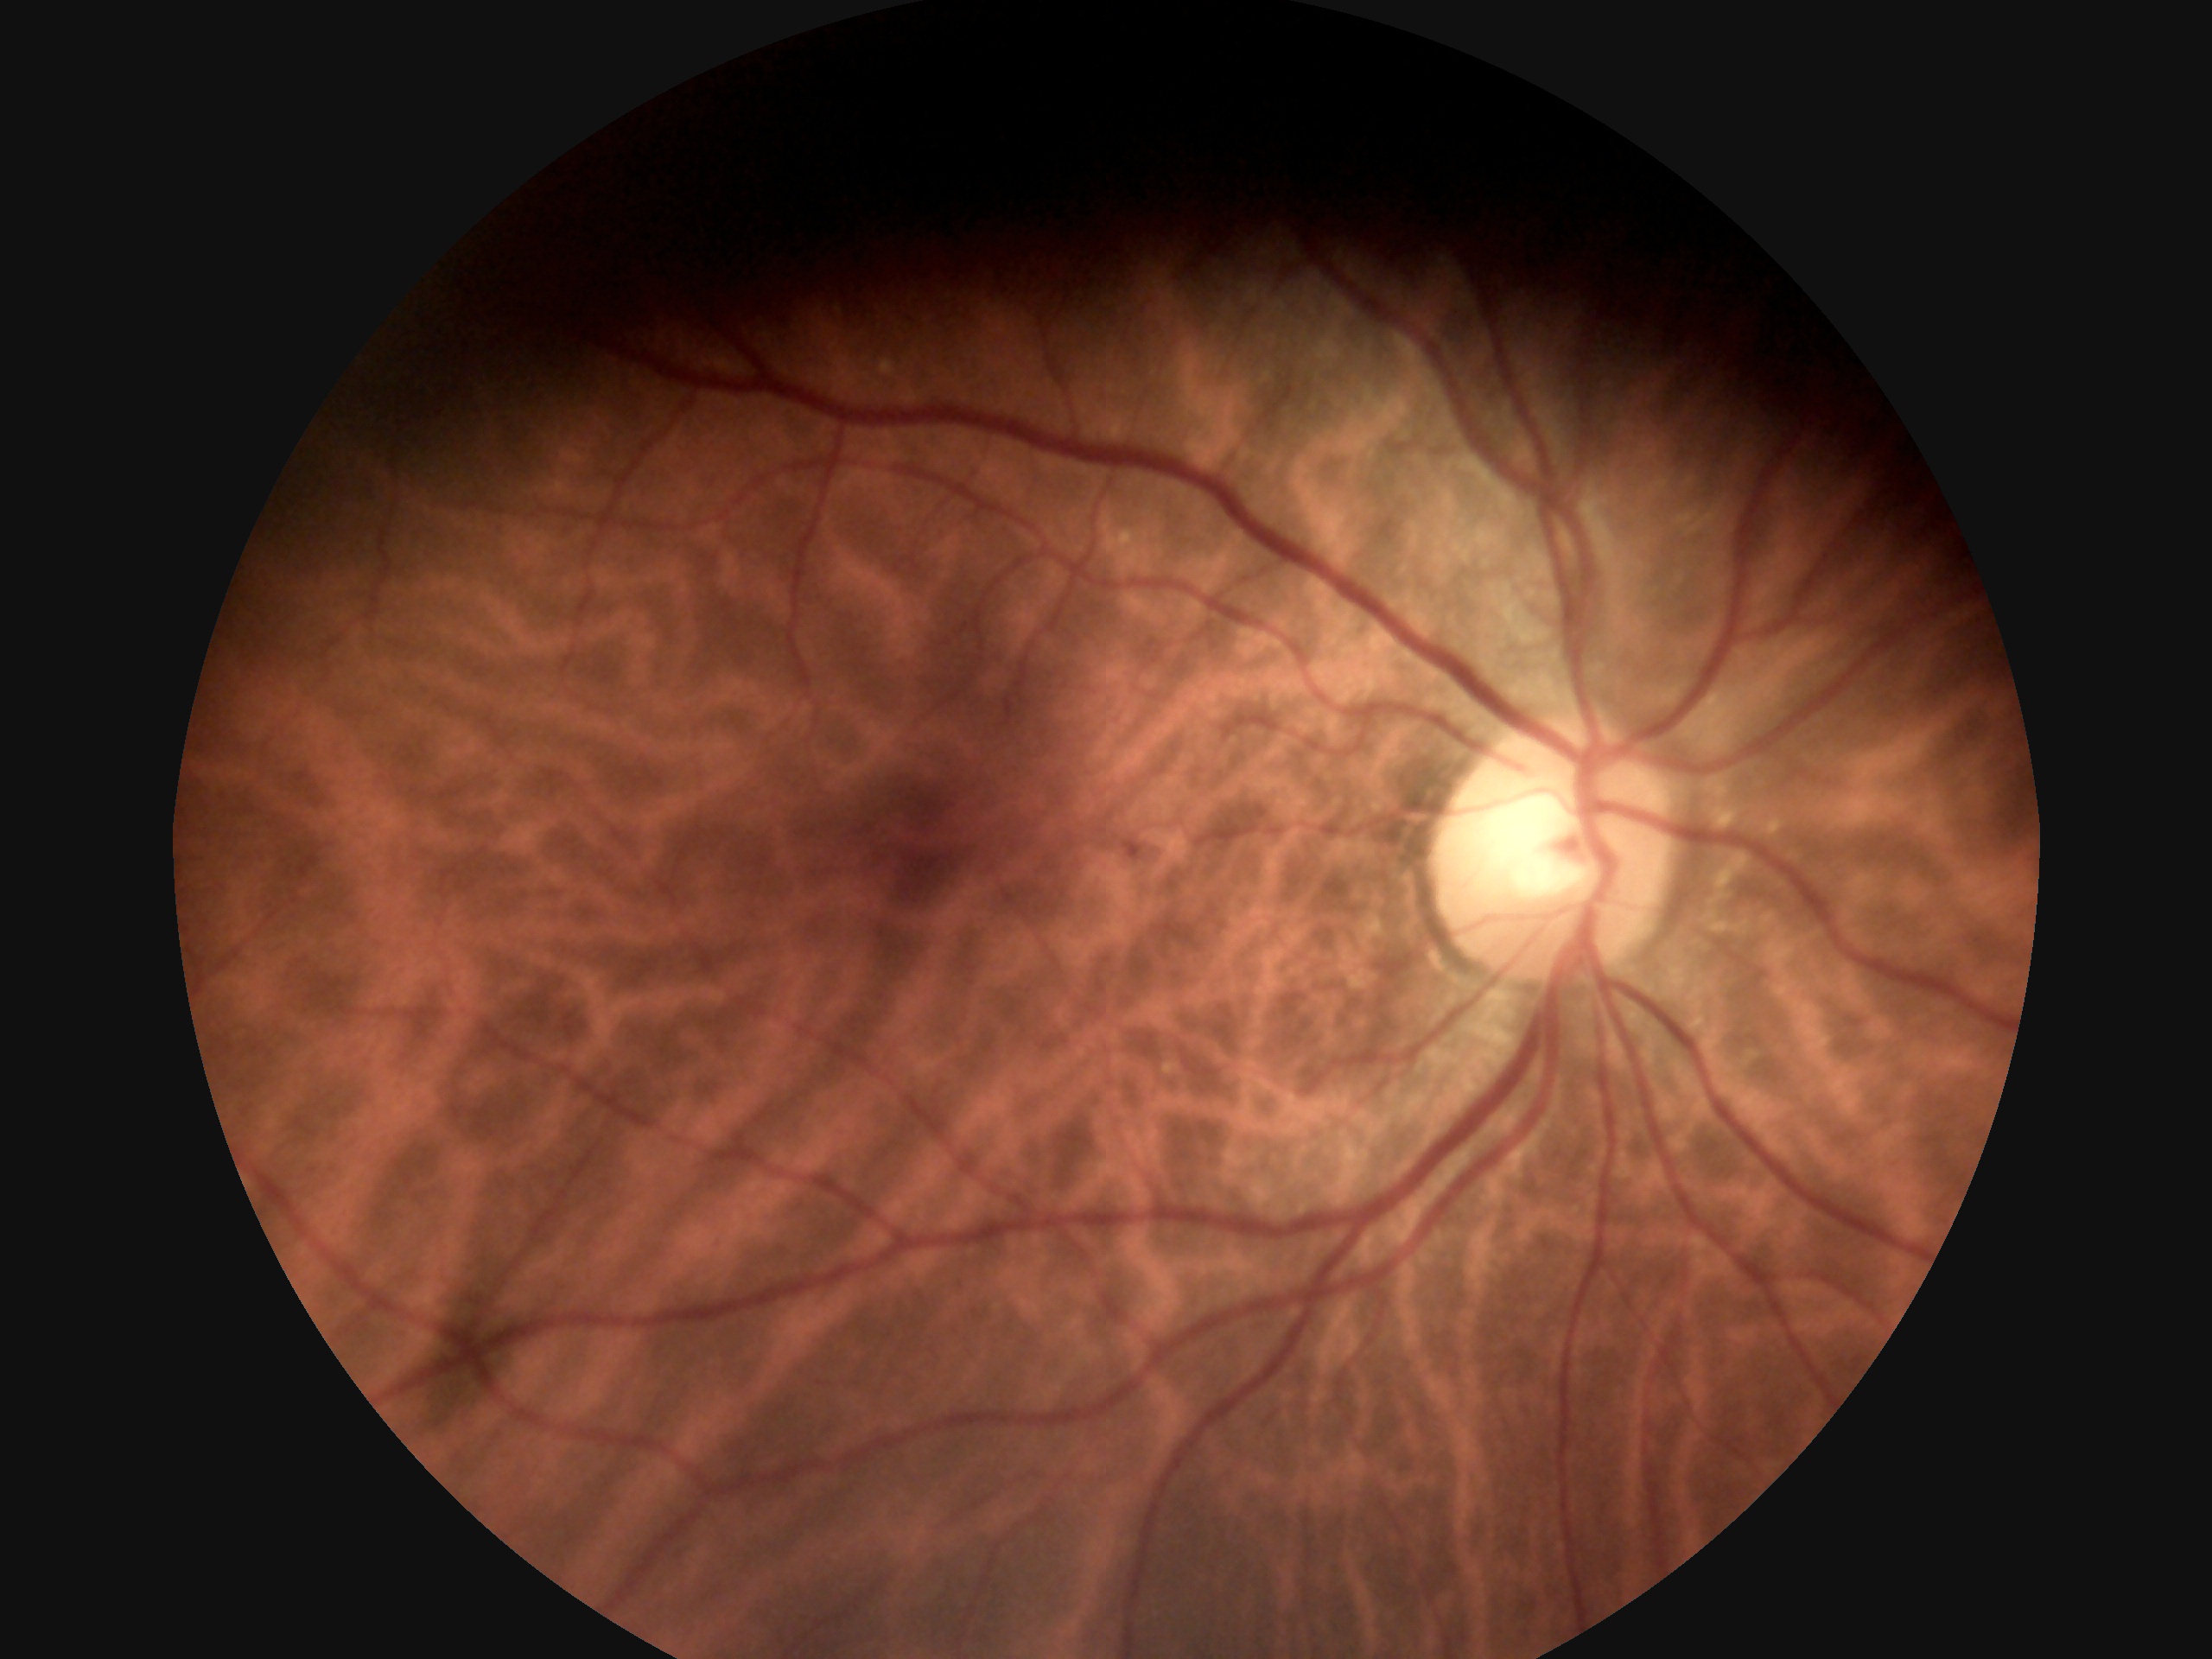

DR grade: 1 (mild NPDR).